Retinal fundus photograph. Image size 1932x1916:
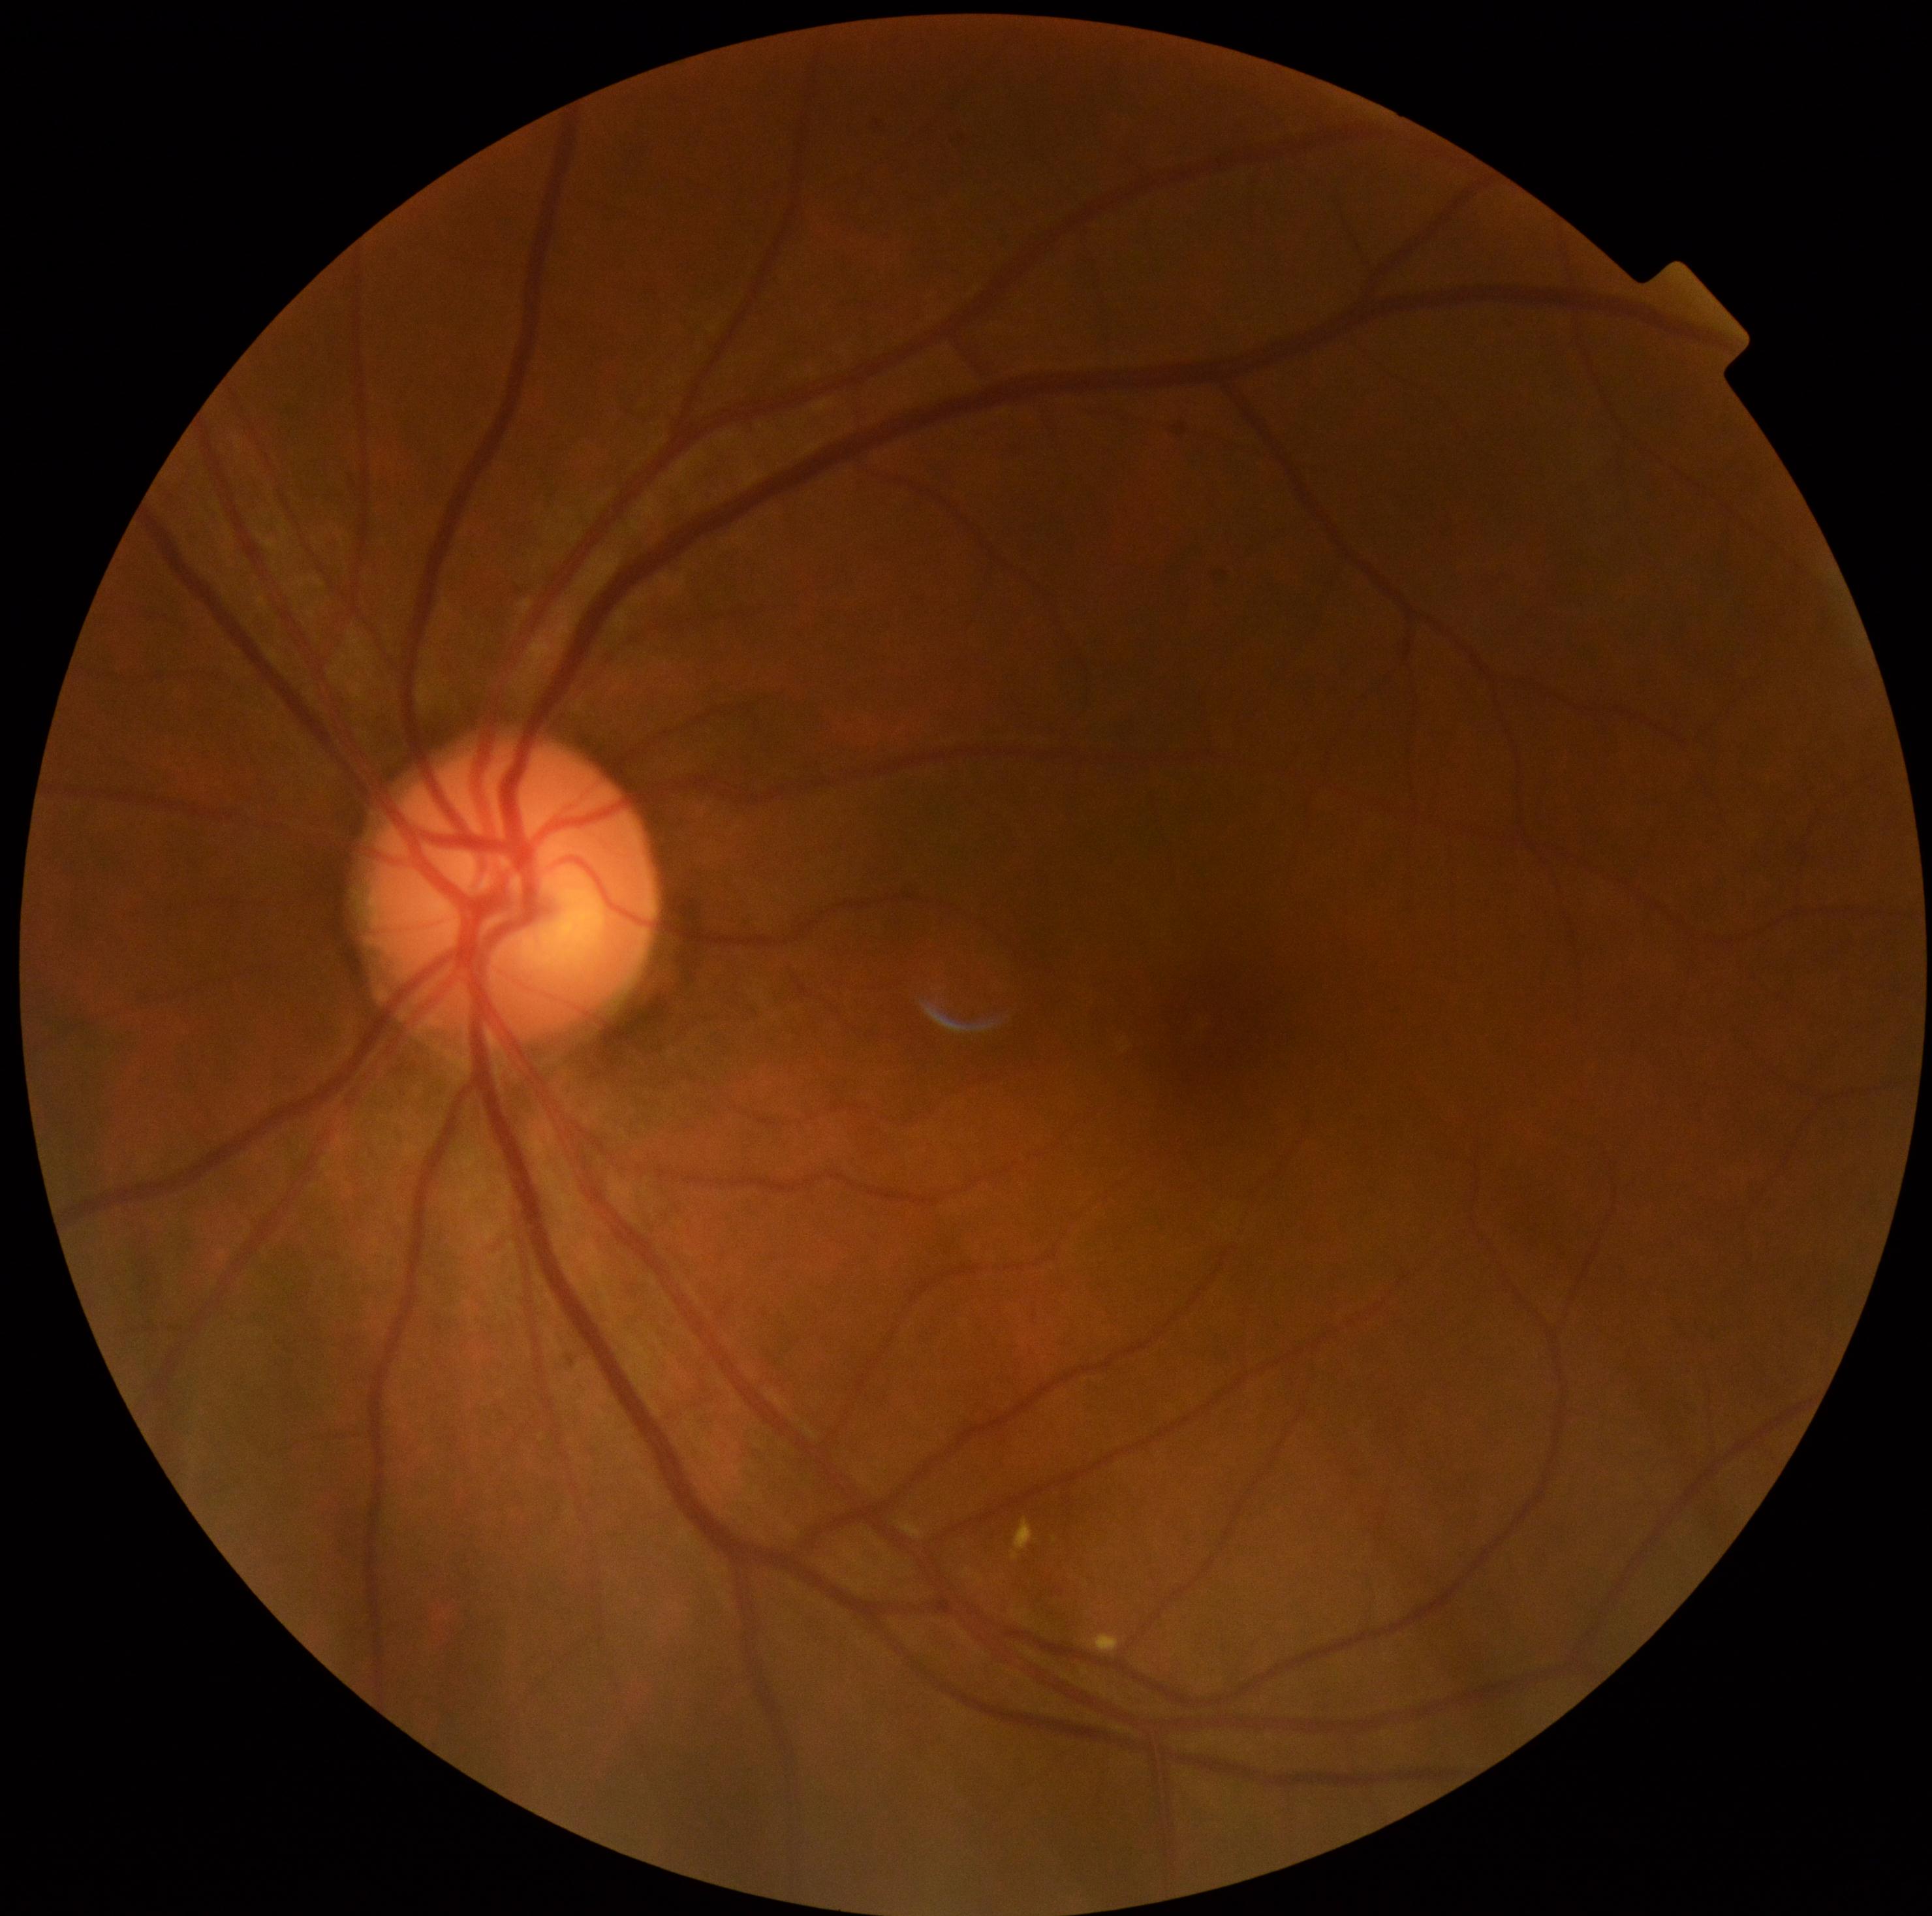

DR class: non-proliferative diabetic retinopathy, diabetic retinopathy severity: moderate NPDR (grade 2).